Davis DR grading: 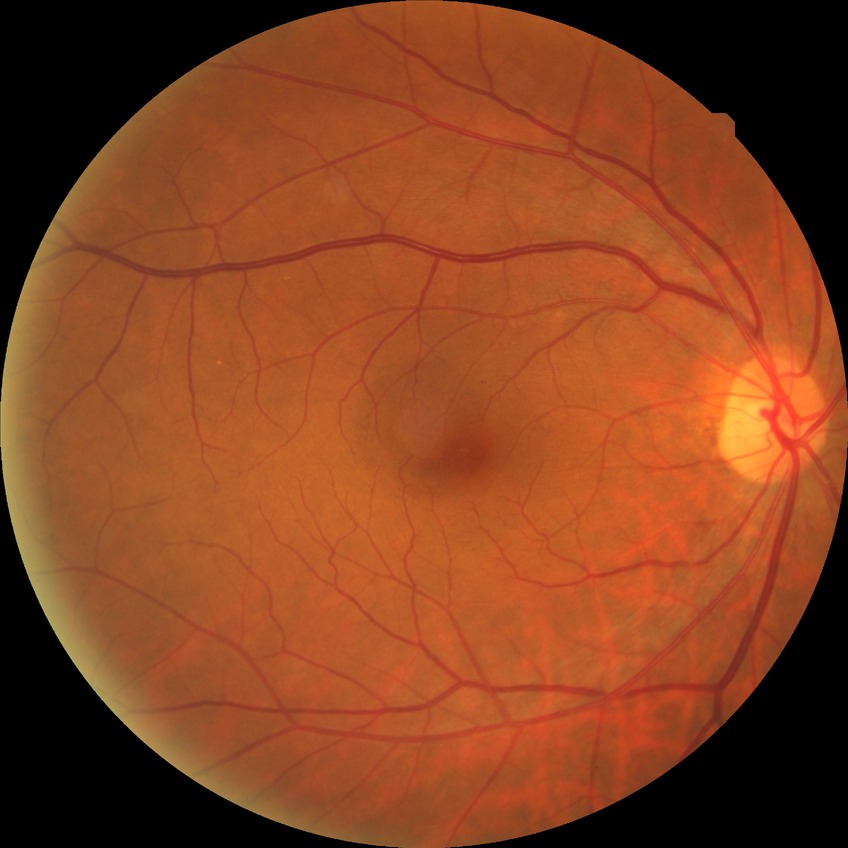 Diabetic retinopathy (DR) is NDR (no diabetic retinopathy).